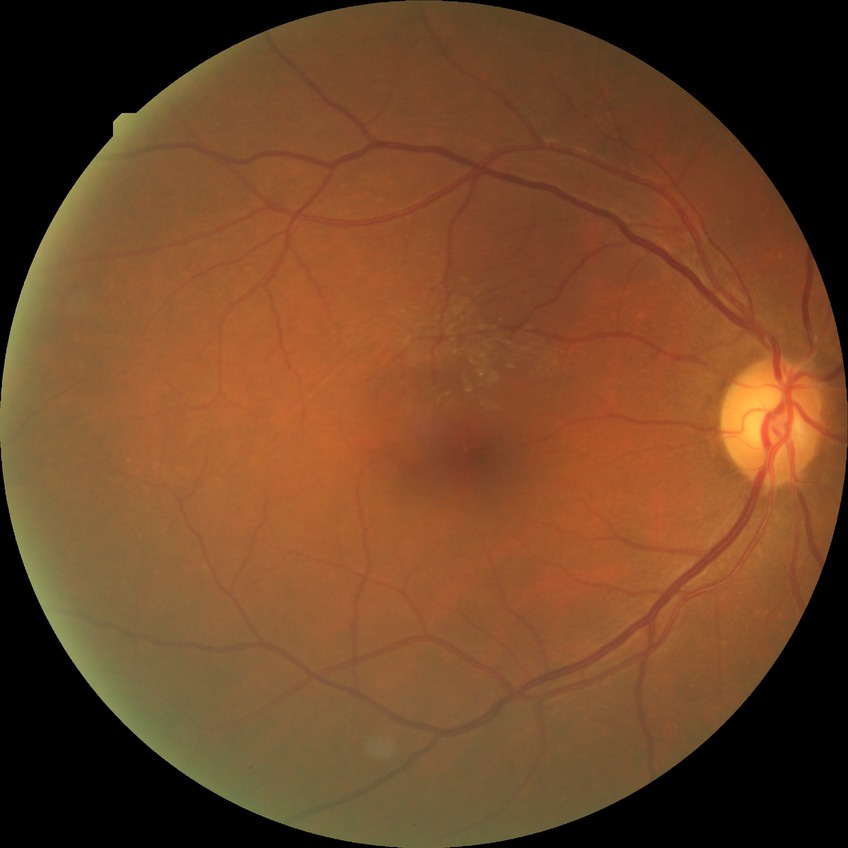 Diabetic retinopathy (DR): simple diabetic retinopathy (SDR).